2352 by 1568 pixels, color fundus photograph:
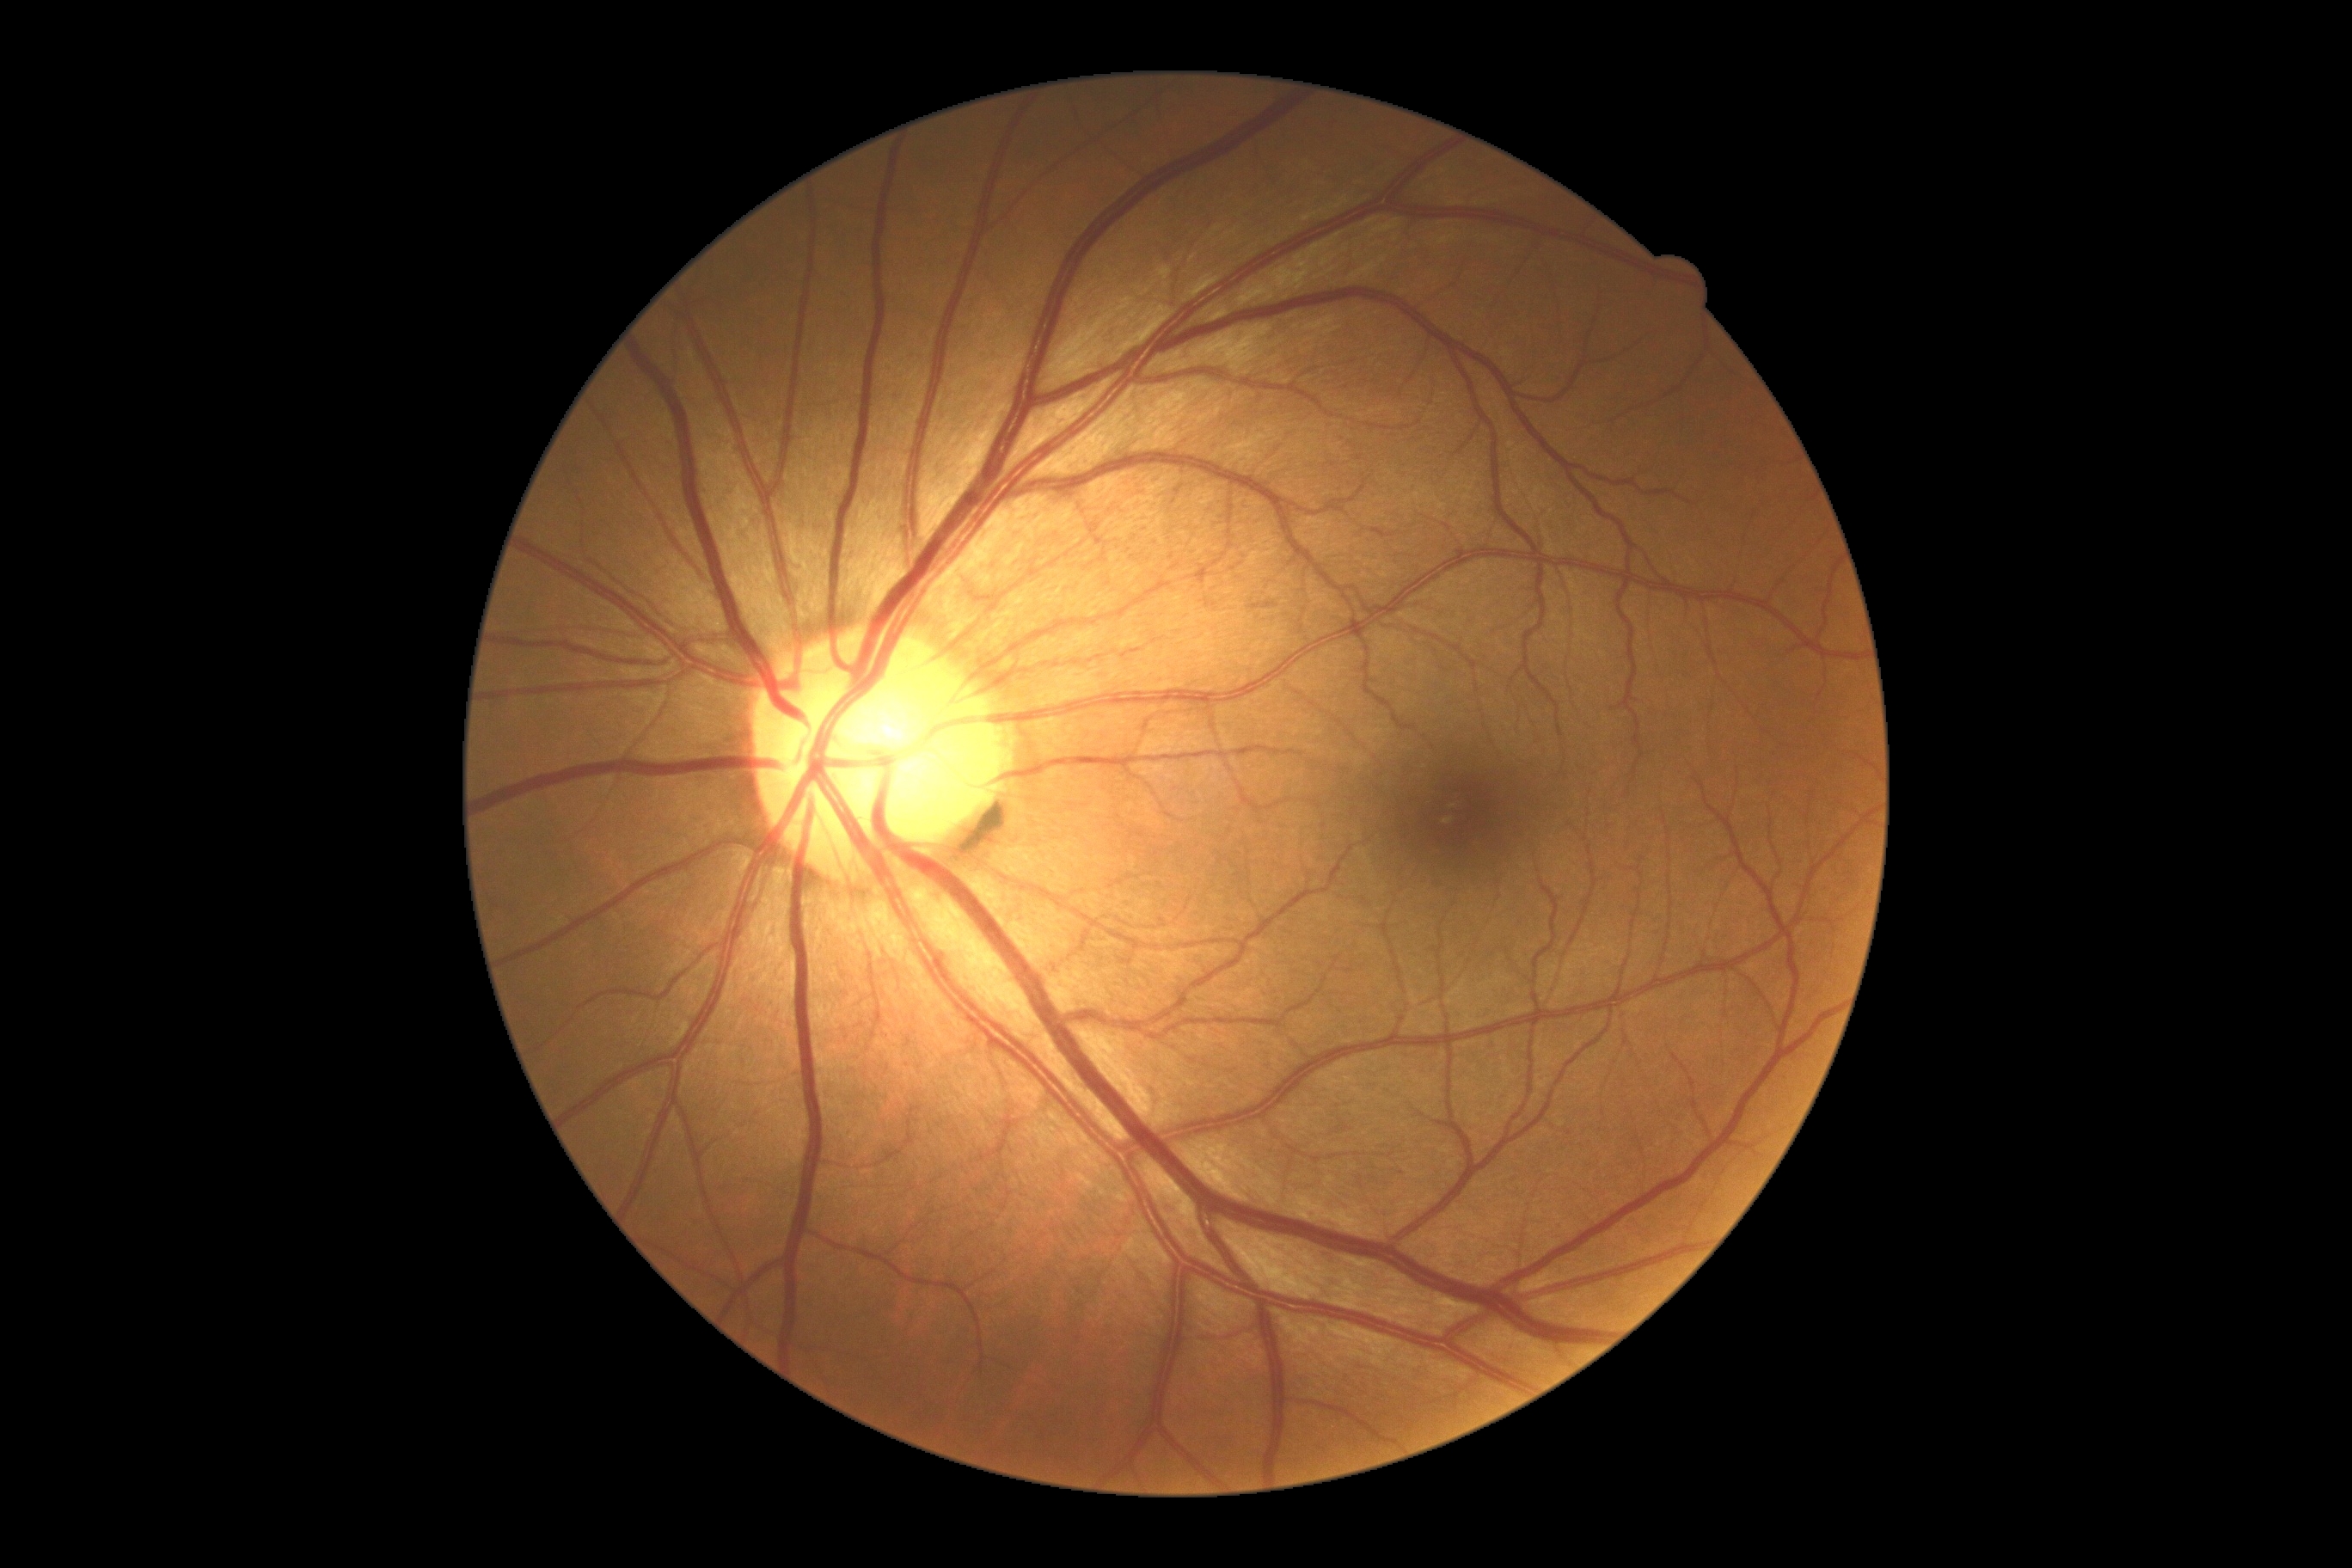 {
  "dr_grade": "0"
}